NIDEK AFC-230 fundus camera. Diabetic retinopathy graded by the modified Davis classification — 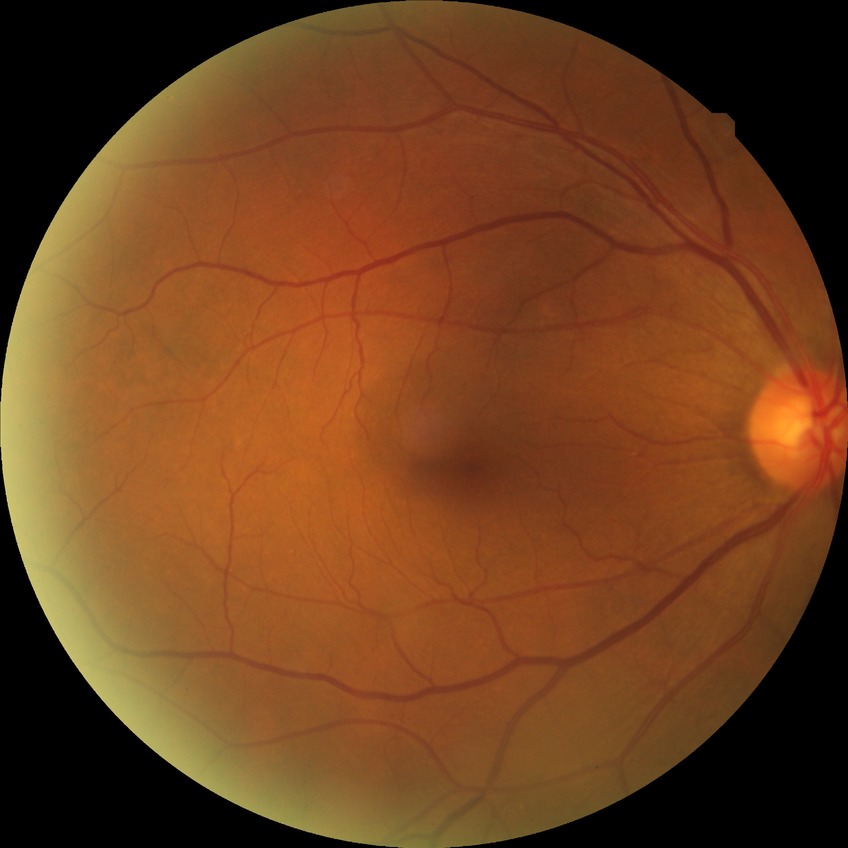 DR: SDR.